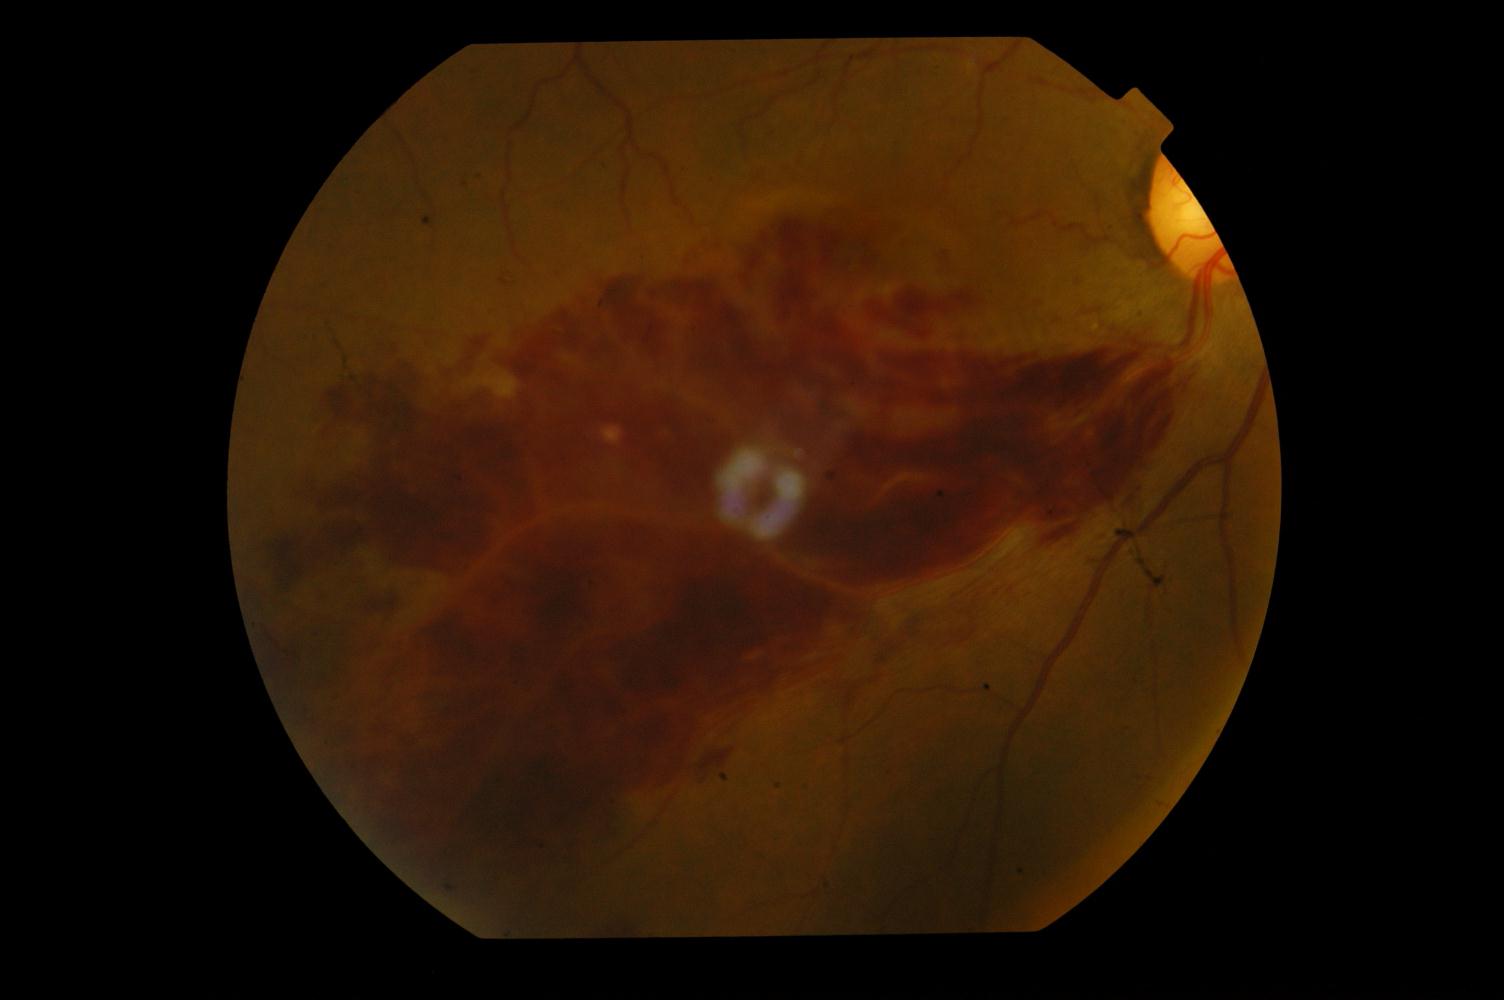
Fundus image with findings of branch retinal vein occlusion.